Nonmydriatic.
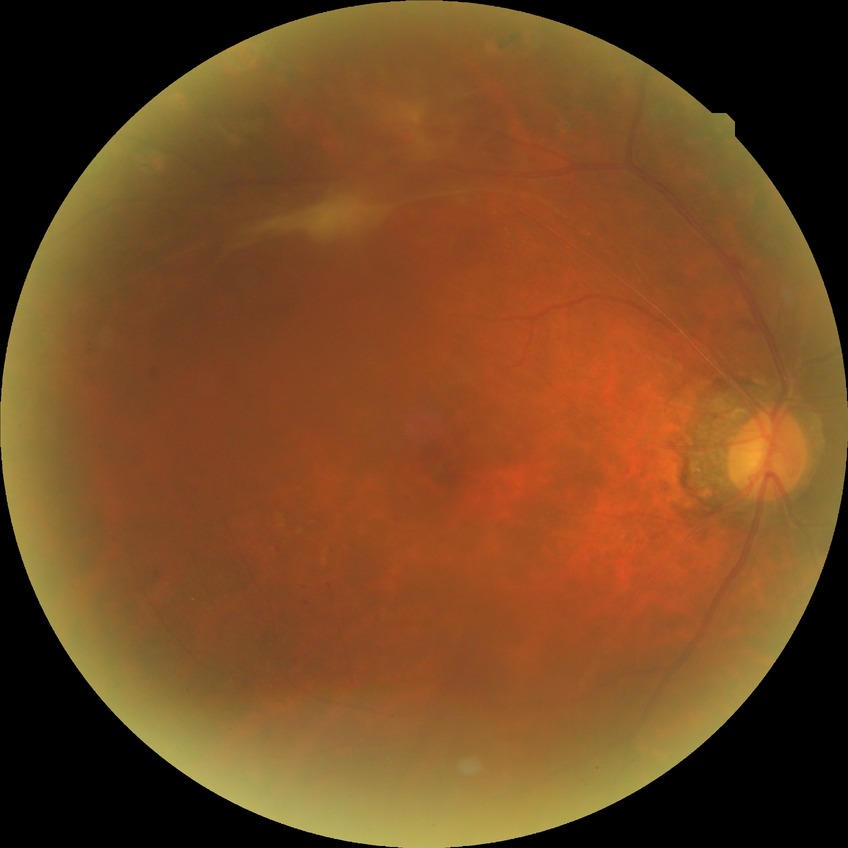
Davis DR grade: PDR.